Wide-field contact fundus photograph of an infant; 130° field of view (Clarity RetCam 3) — 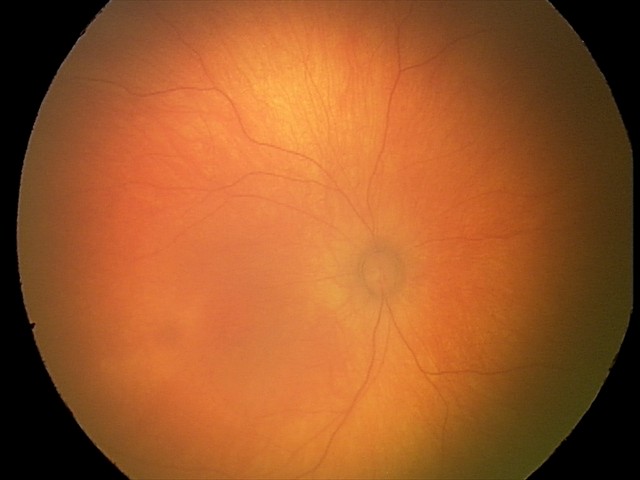 Screening examination with no abnormal retinal findings.